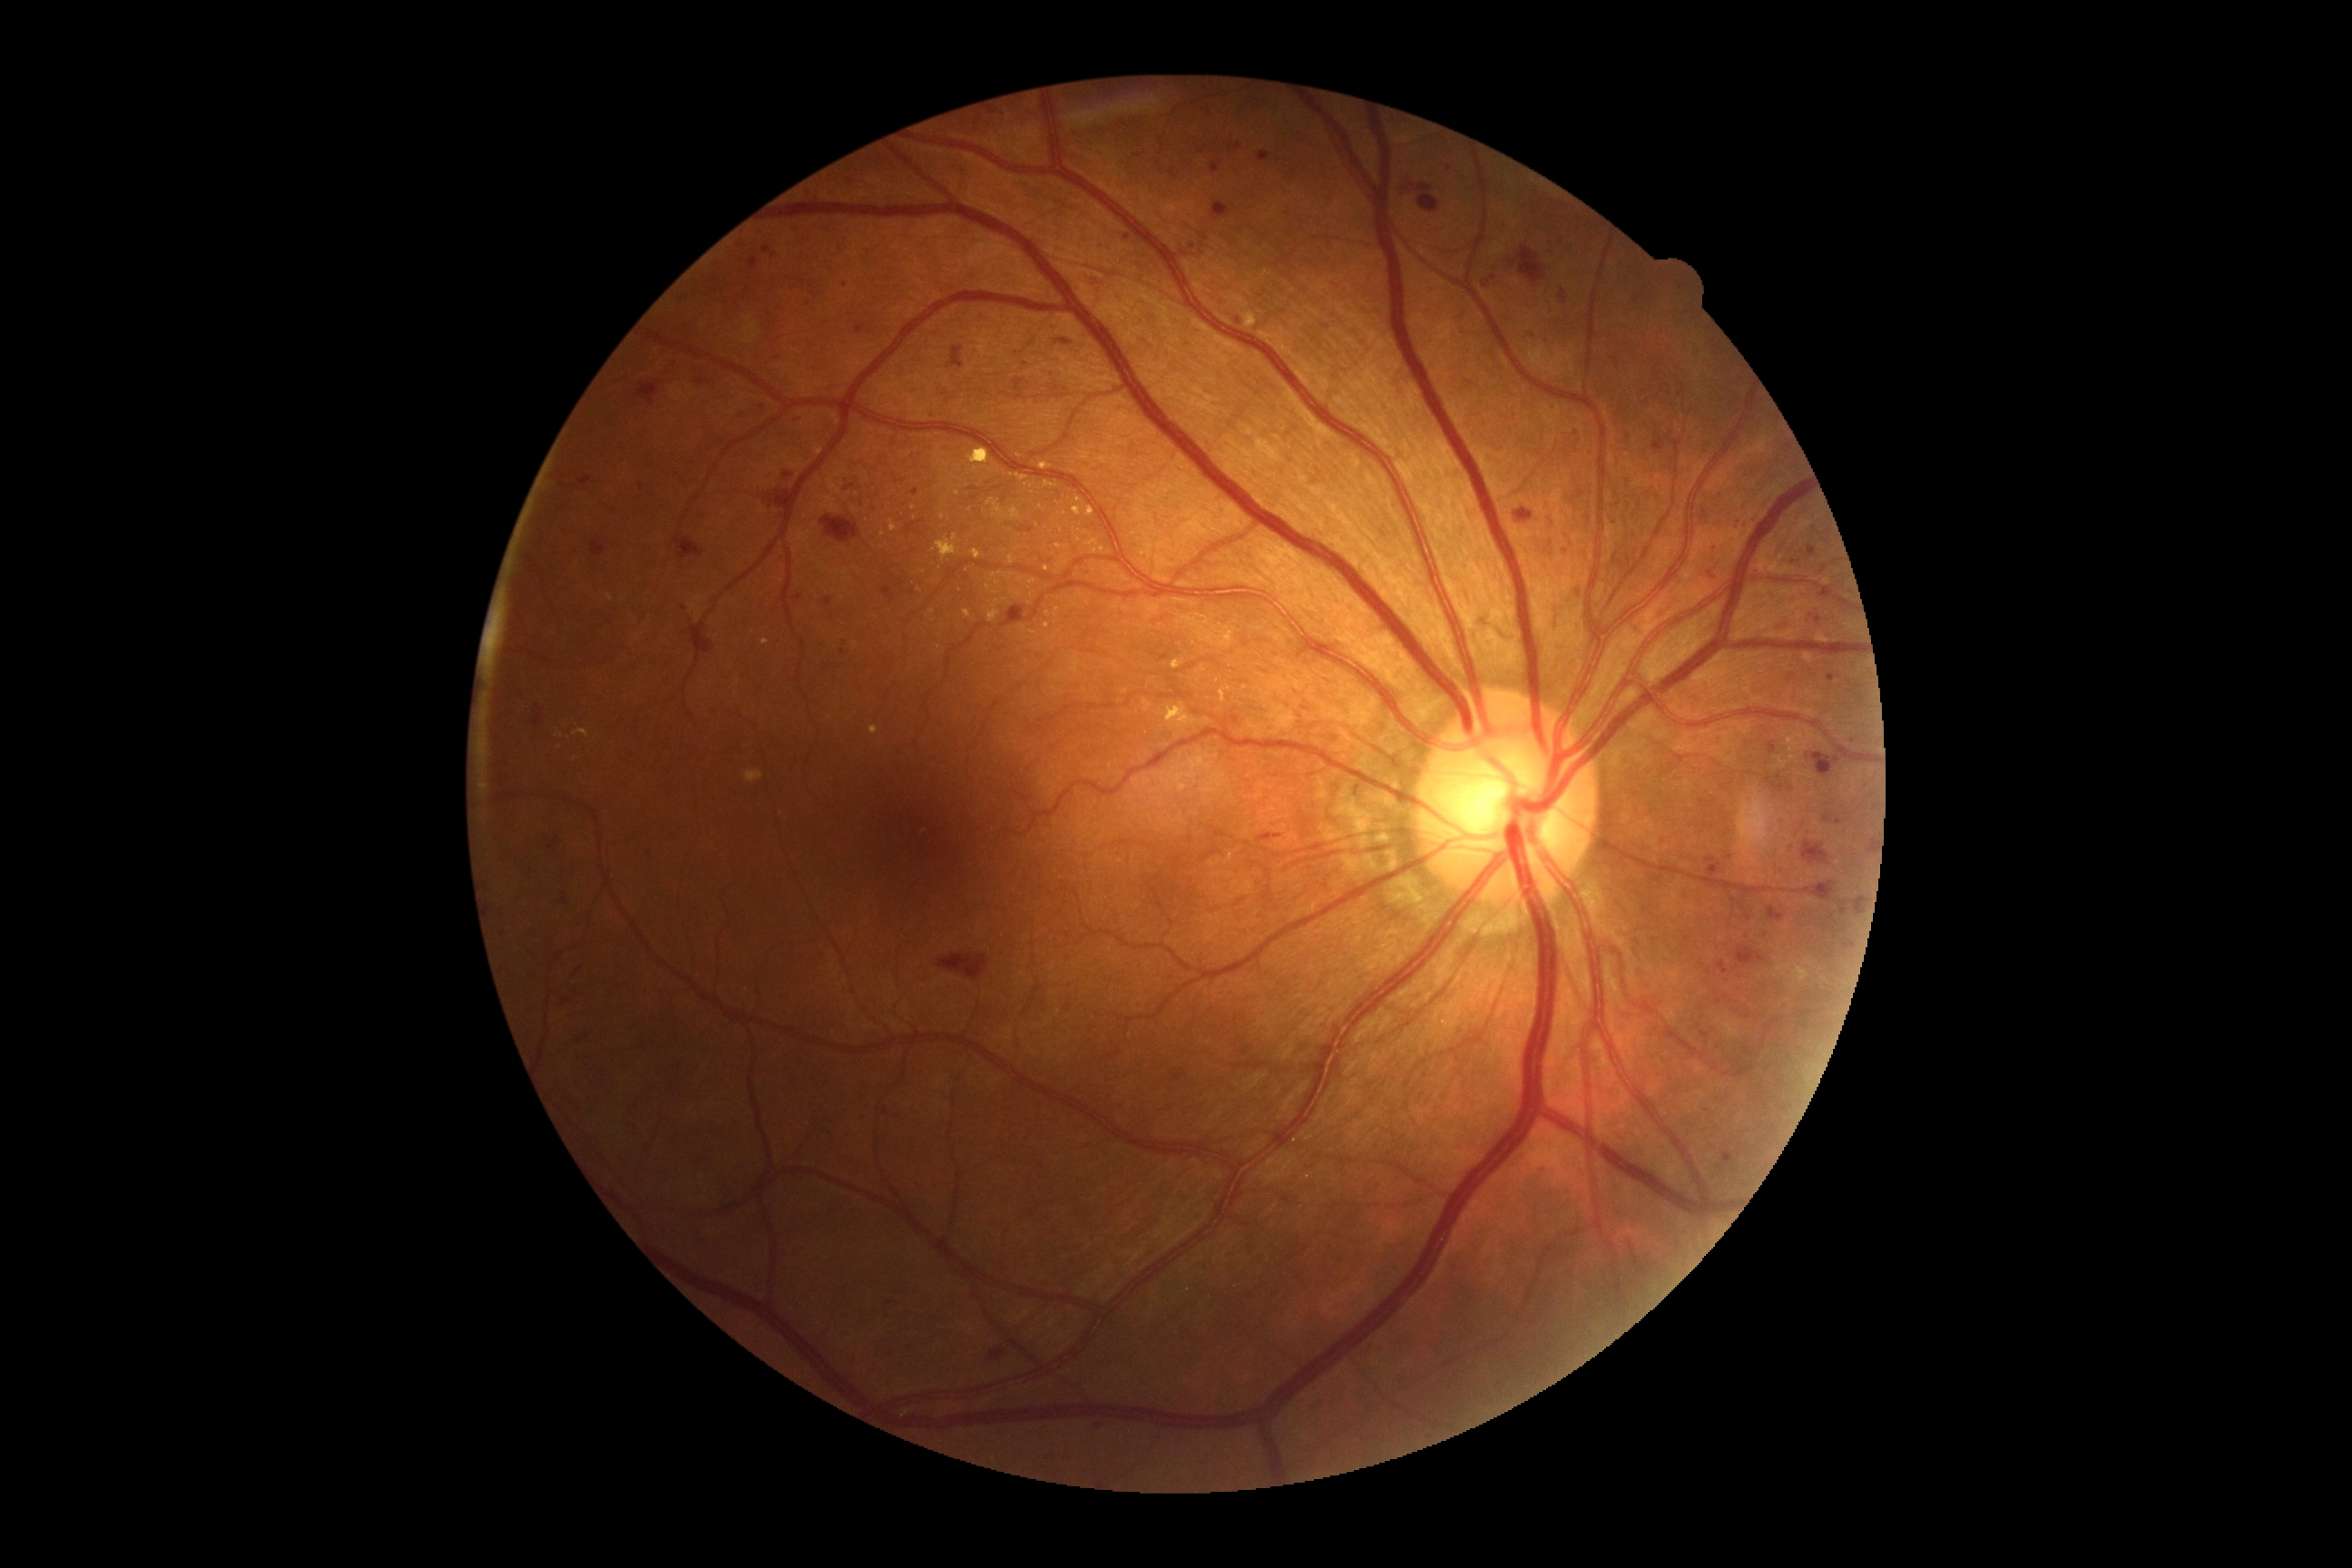

<lesions partial="true">
  <dr_grade>2</dr_grade>
  <ma partial="true"><box>1228,142,1242,153</box> | <box>856,326,865,335</box> | <box>763,246,770,255</box> | <box>883,587,896,602</box> | <box>770,253,778,259</box> | <box>1257,152,1271,161</box> | <box>1235,318,1242,326</box> | <box>1769,741,1778,754</box></ma>
  <ma_small_centers>845/286 | 1139/157 | 1576/433 | 1769/1069 | 1846/816 | 1669/394 | 500/738 | 1747/506 | 1123/123</ma_small_centers>
</lesions>